Color fundus photograph · 2048x1536 — 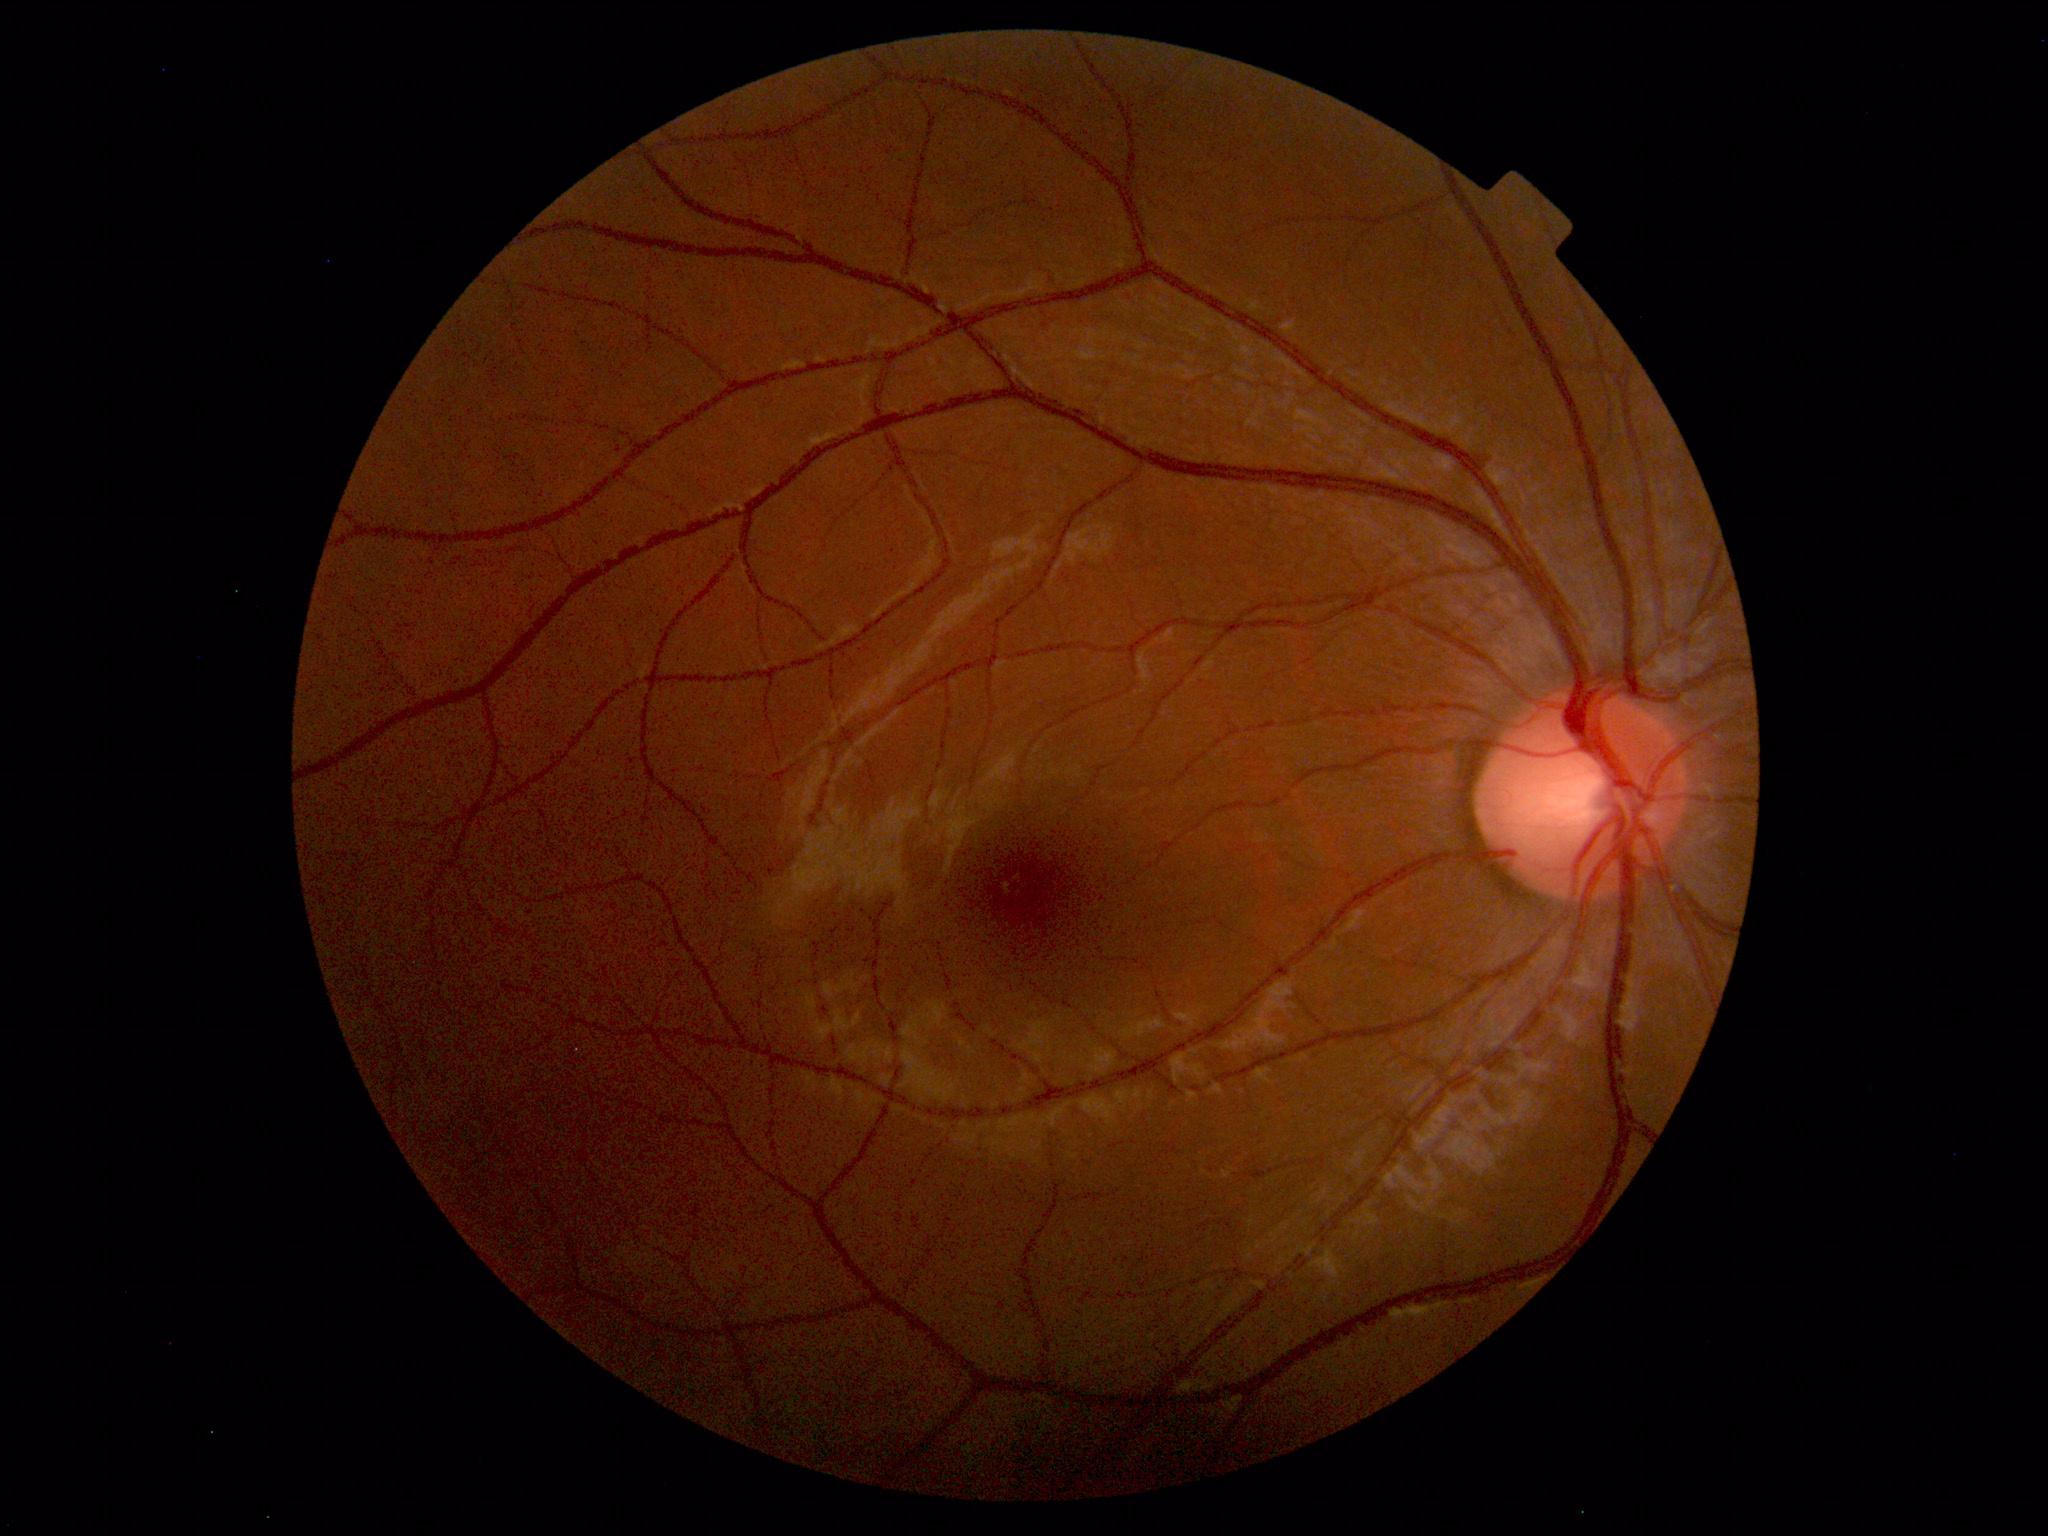

No abnormal findings on fundus examination.